Graded on the modified Davis scale, camera: NIDEK AFC-230.
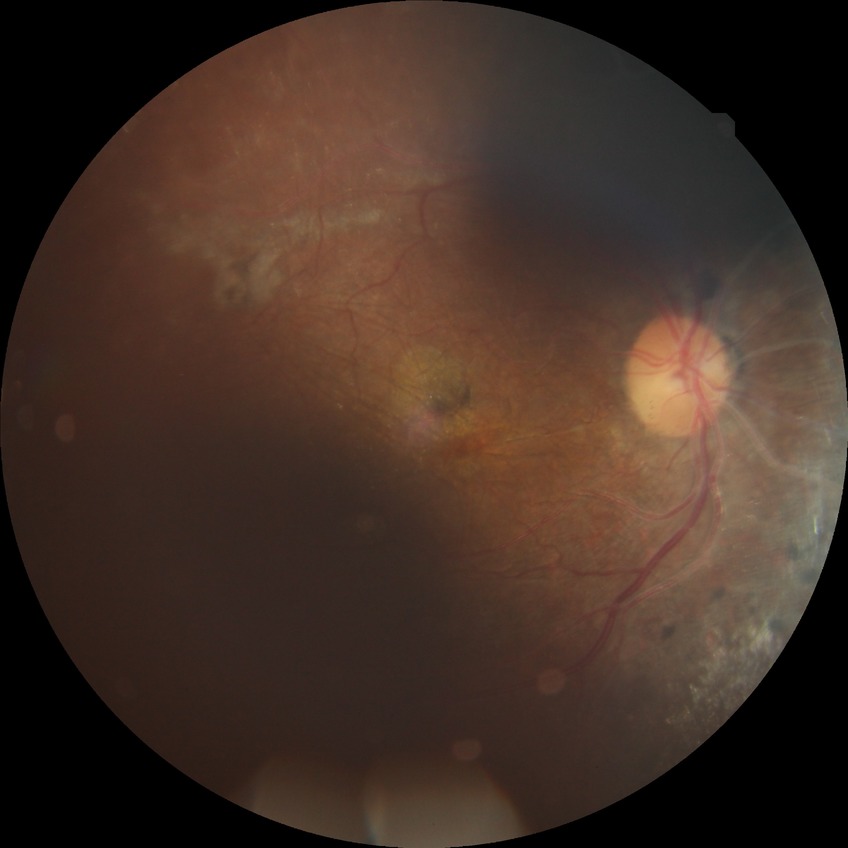
Modified Davis classification is proliferative diabetic retinopathy.